Infant wide-field fundus photograph:
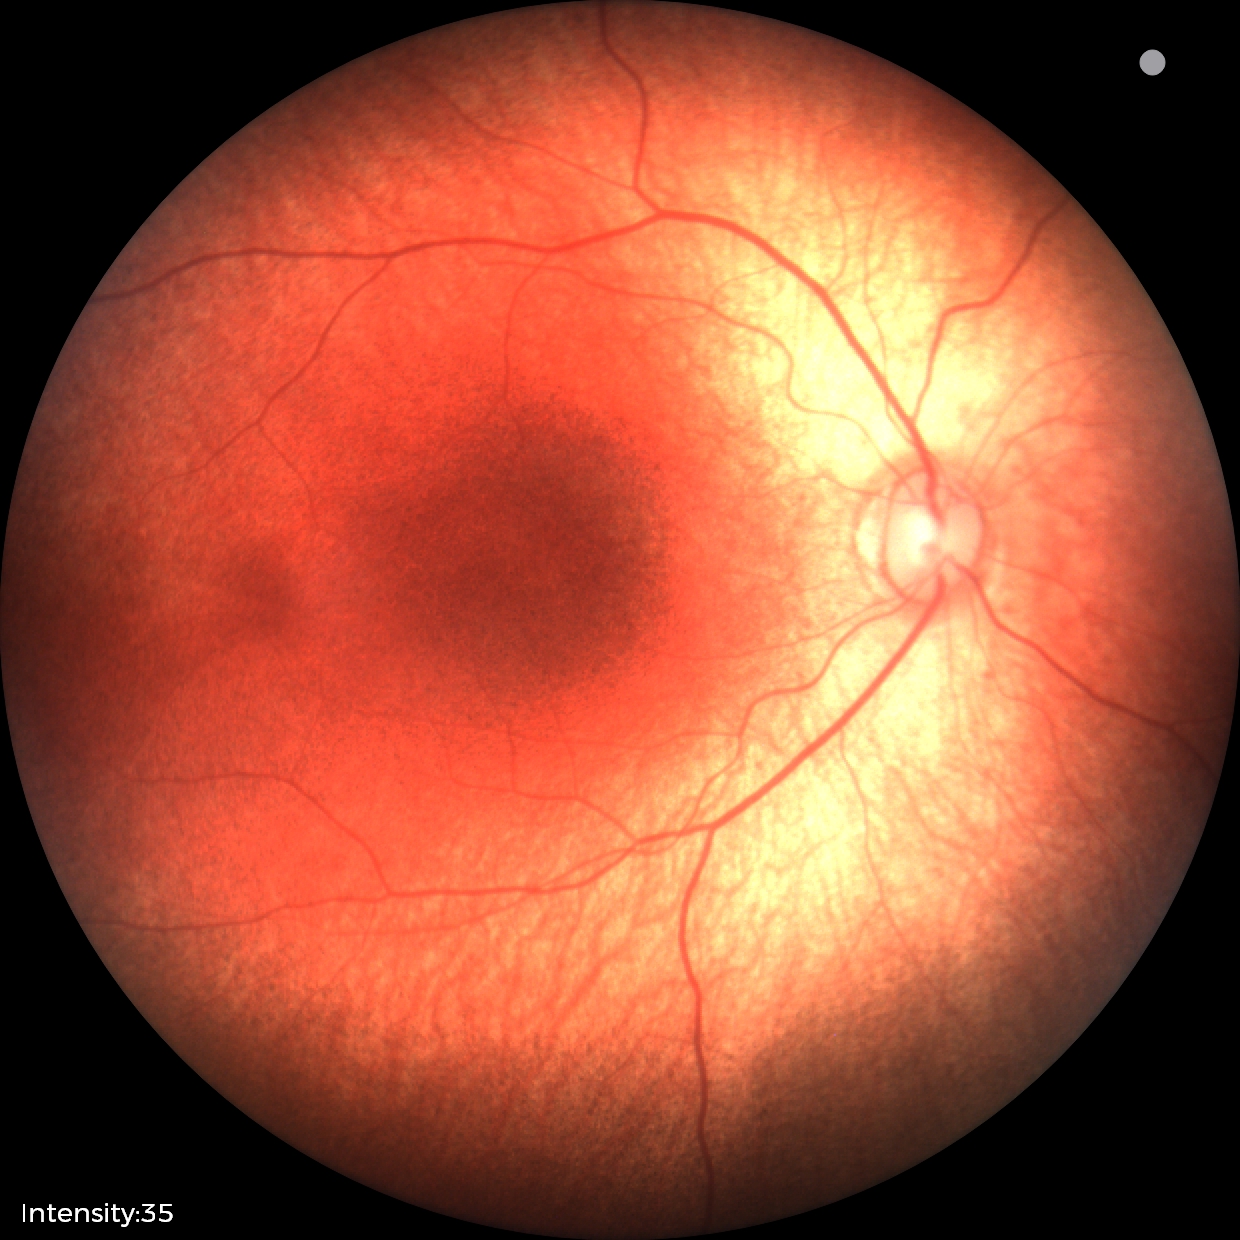 No retinal pathology identified on screening.